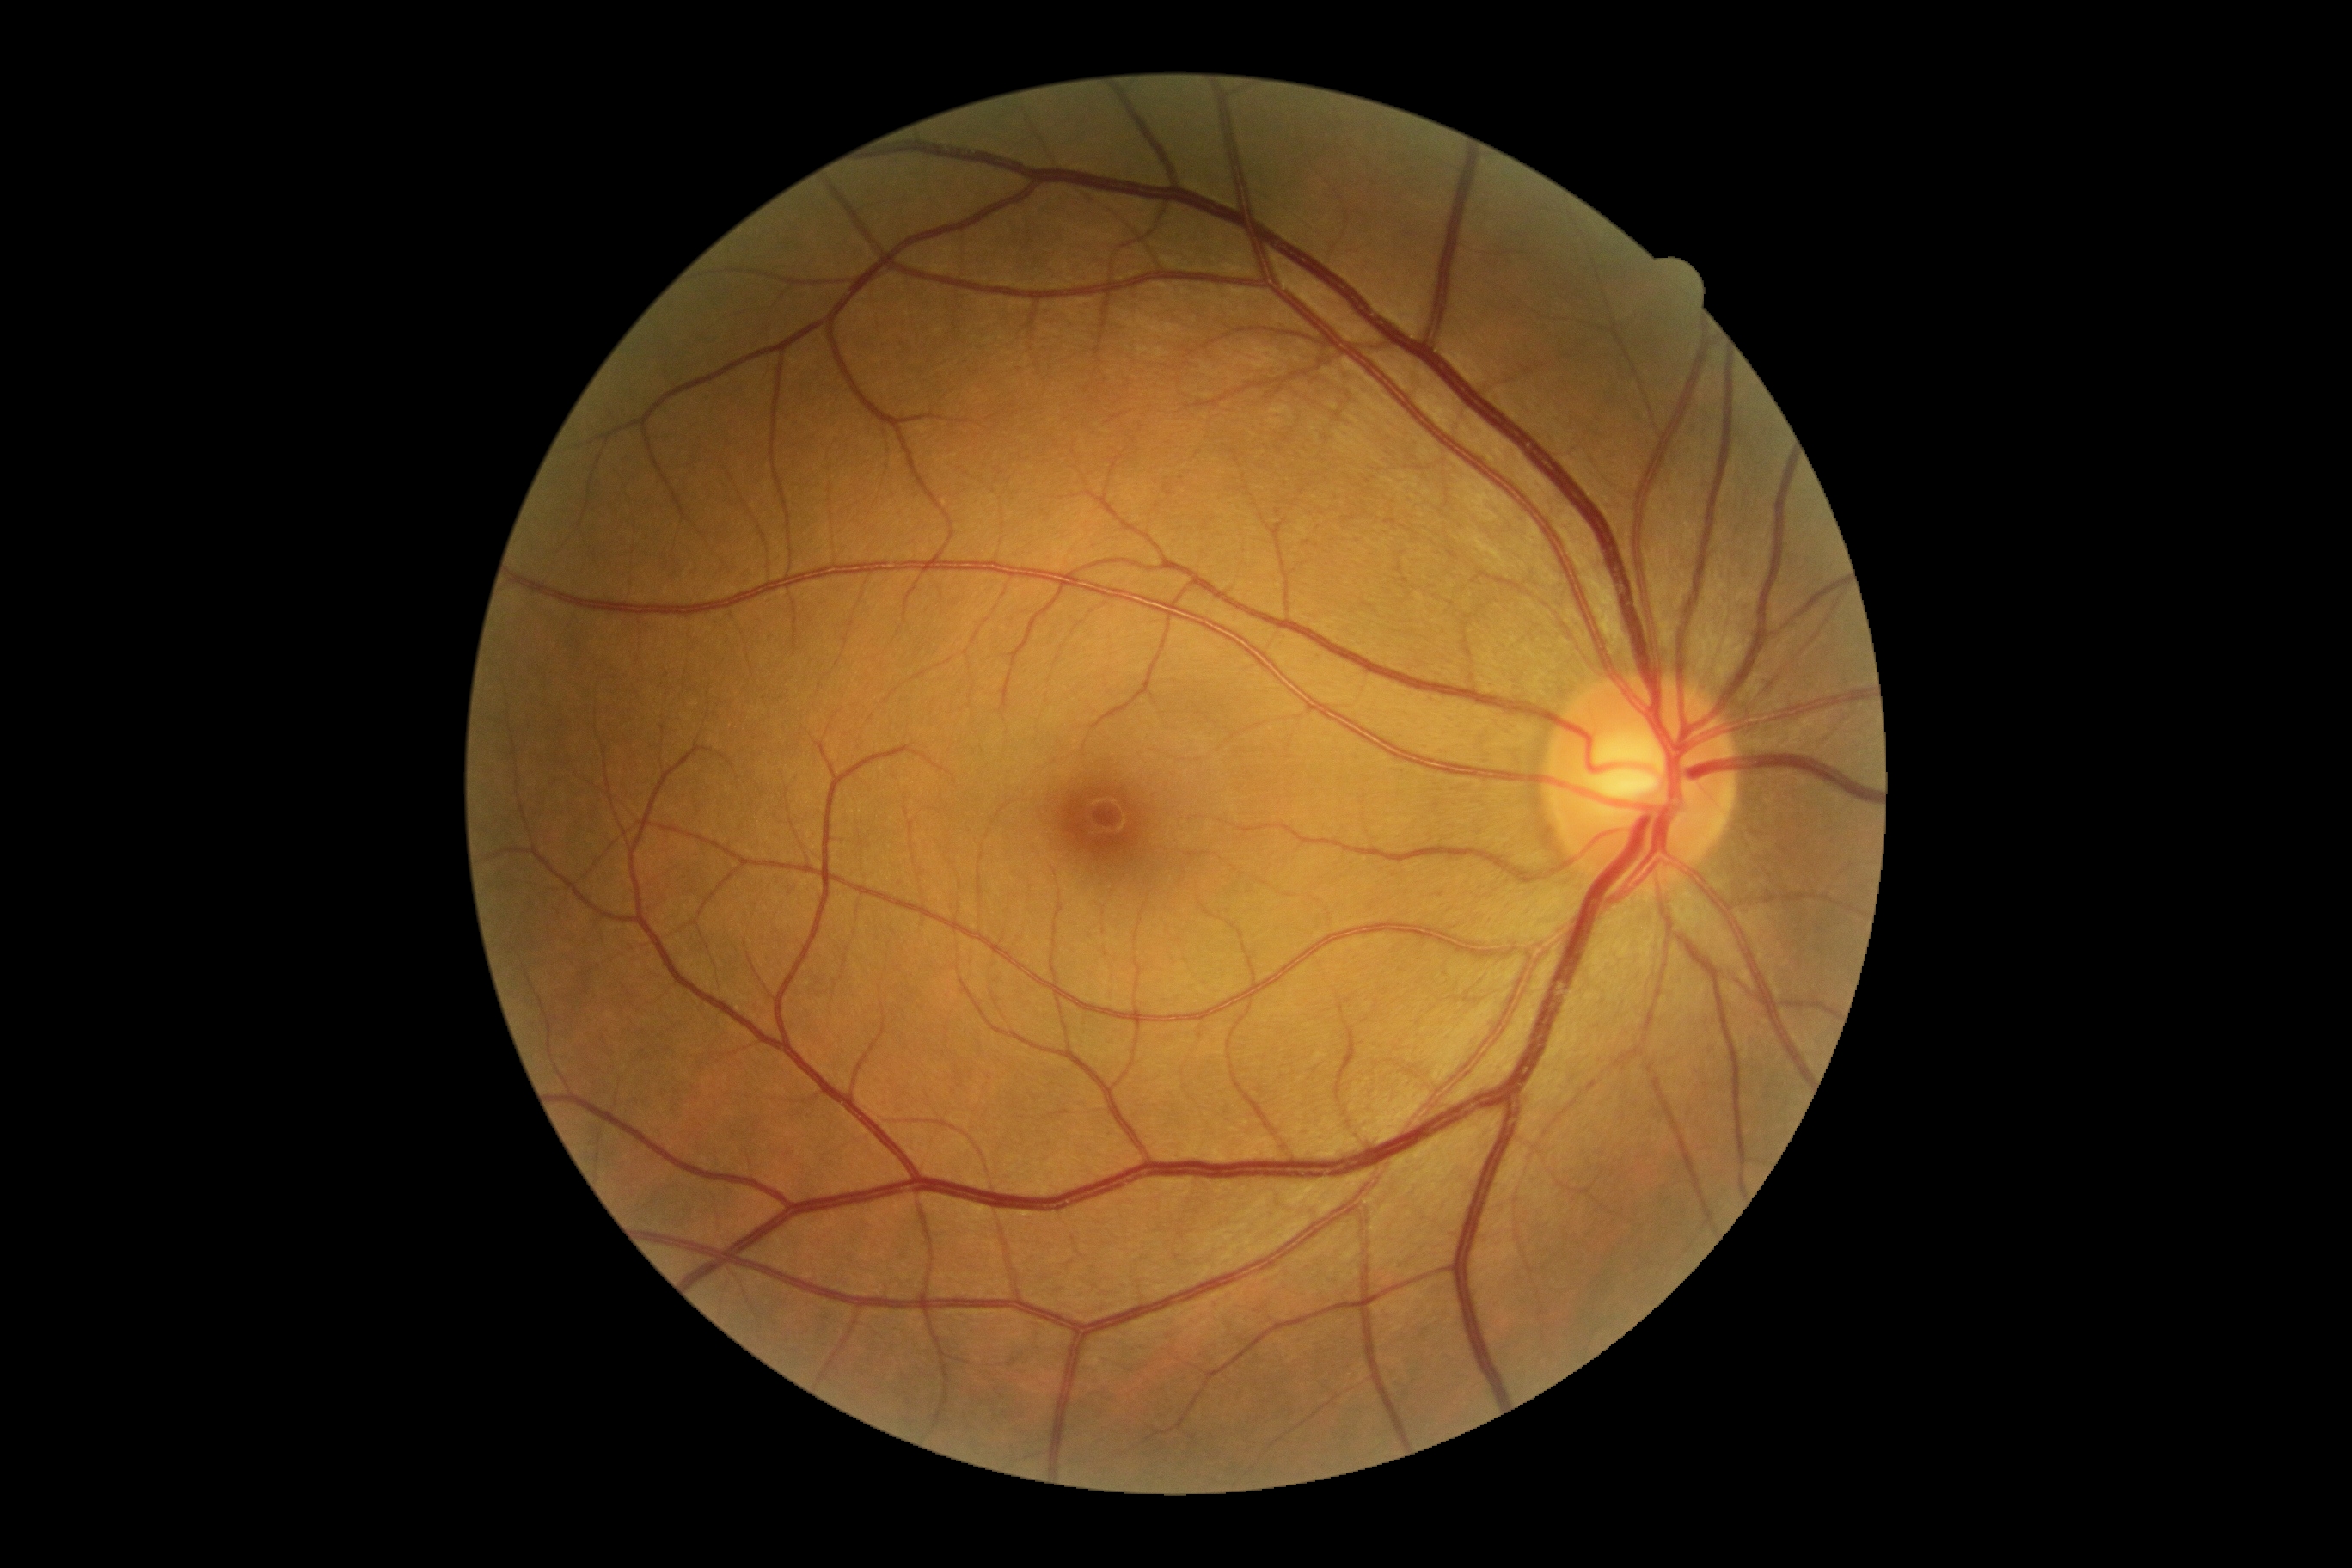 No apparent diabetic retinopathy. Diabetic retinopathy (DR): grade 0 (no apparent retinopathy).